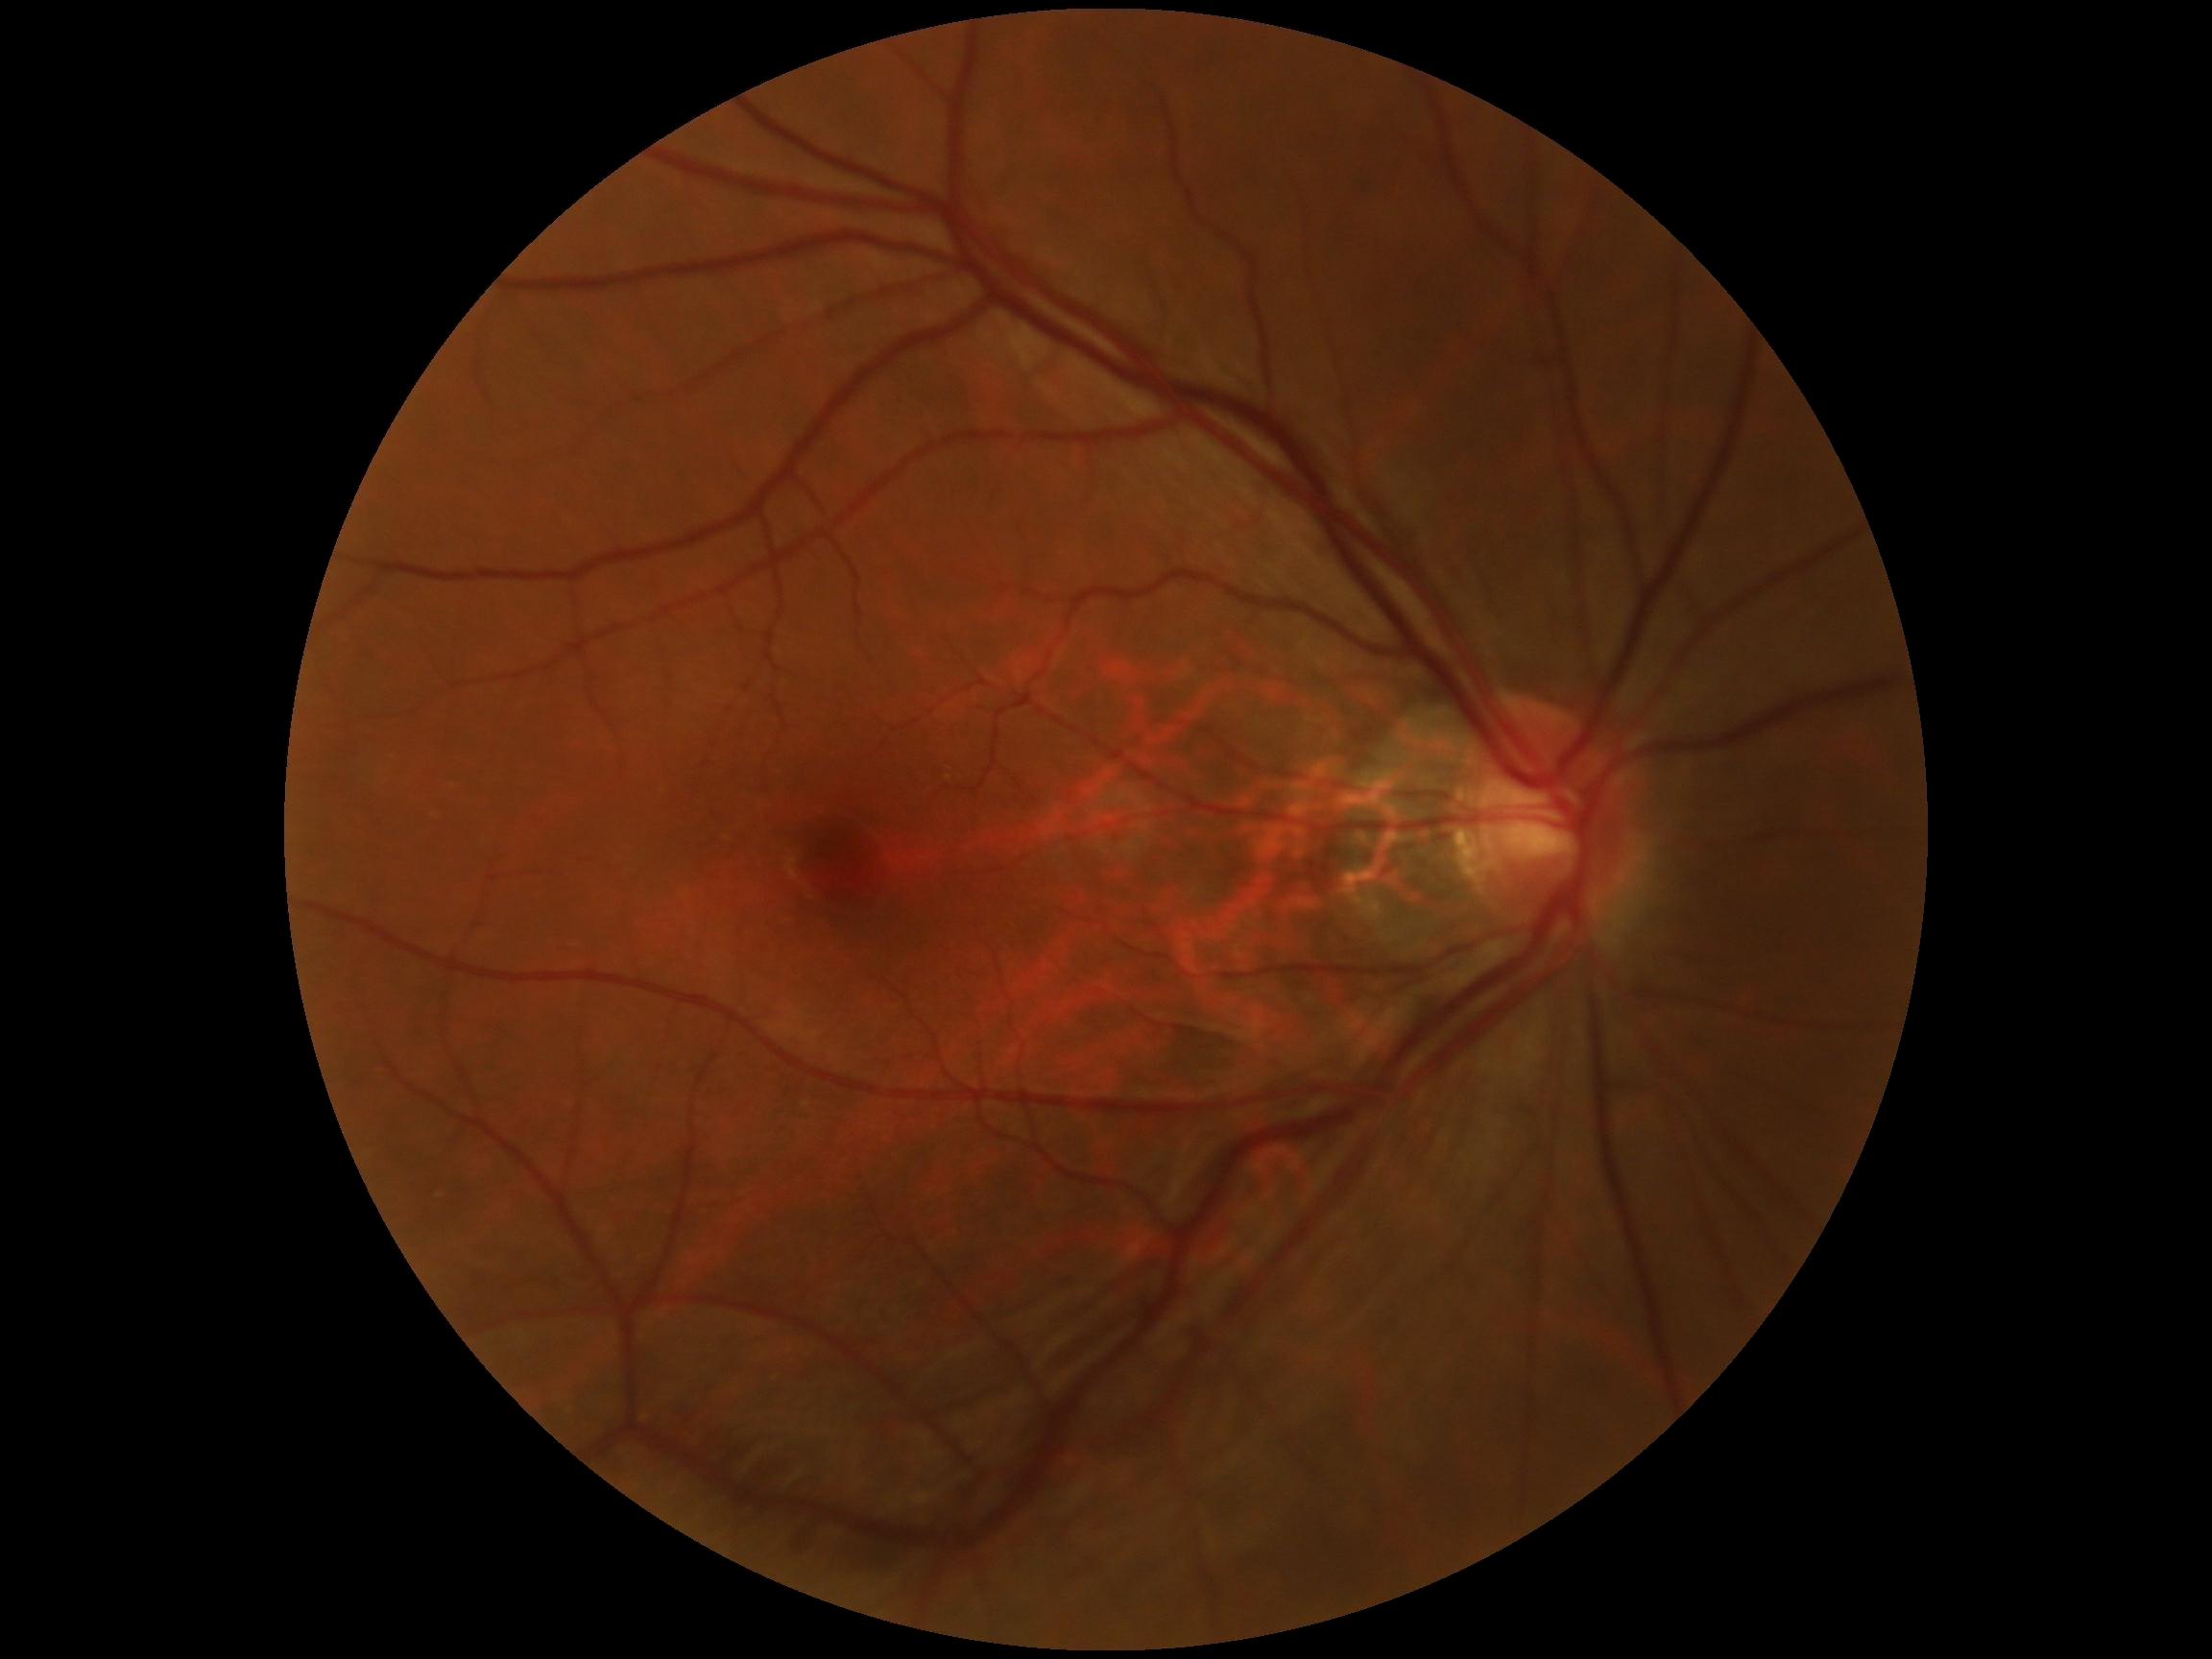
Diabetic retinopathy severity is grade 0 (no apparent retinopathy).